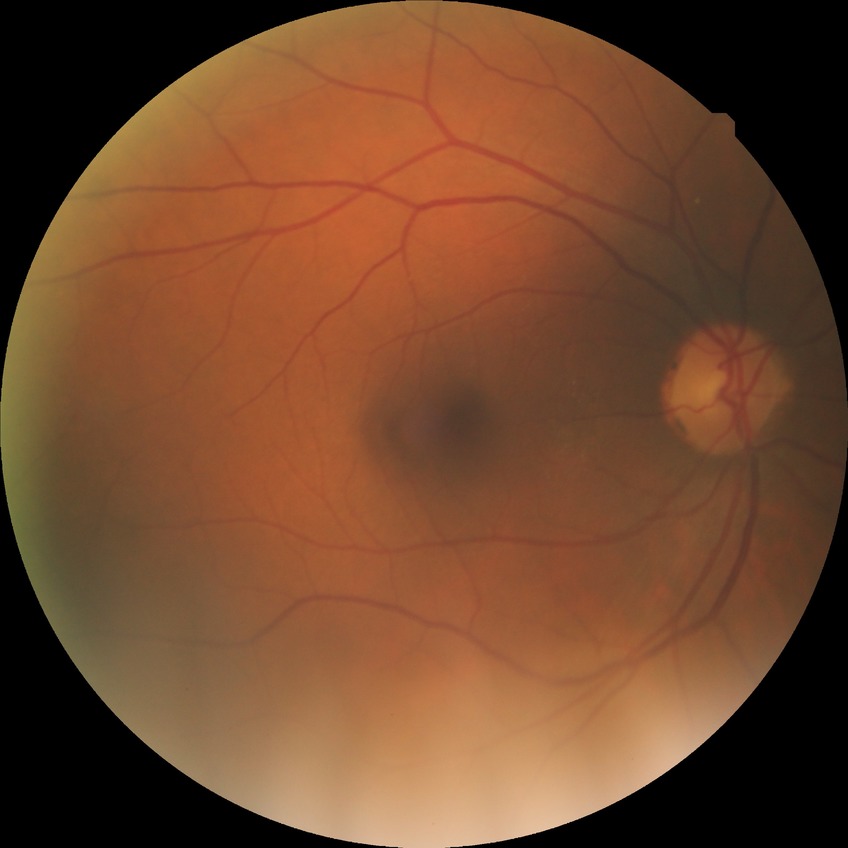
{
  "davis_grade": "no diabetic retinopathy (NDR)"
}